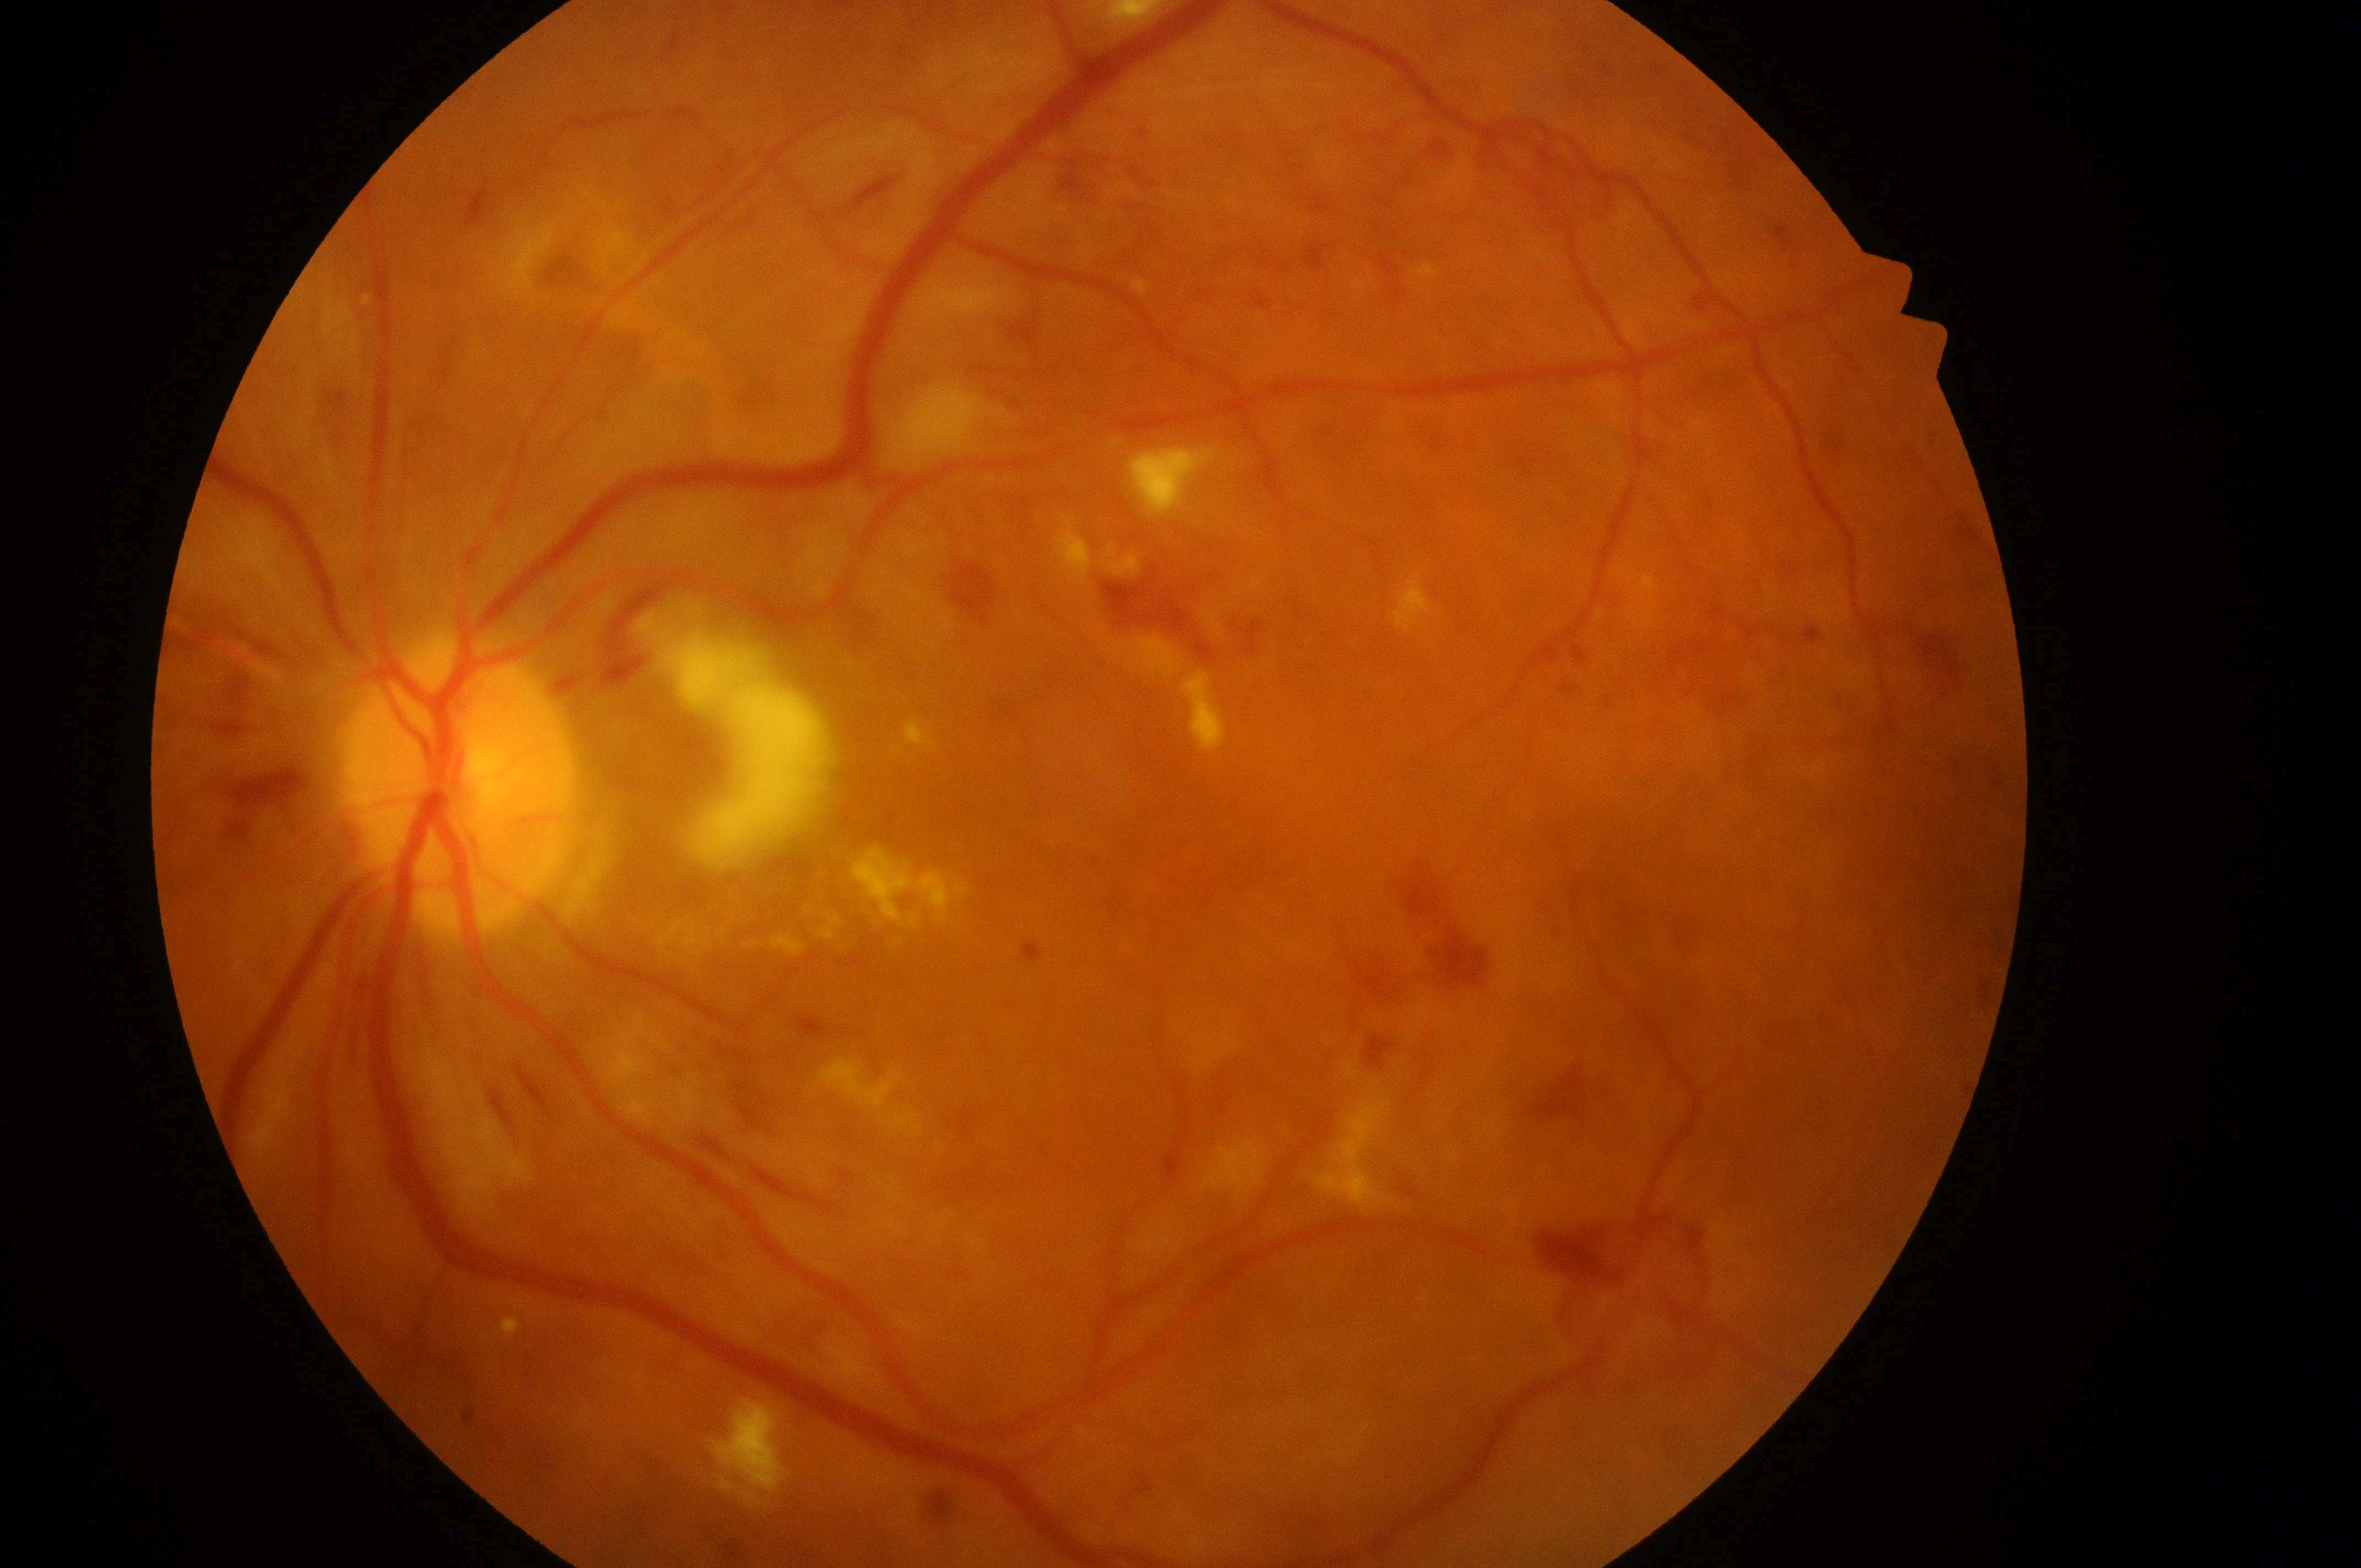

Annotations:
• DR class · proliferative diabetic retinopathy
• macular edema · grade 2 (high risk)
• macular center · 1200px, 853px
• laterality · left
• diabetic retinopathy · proliferative diabetic retinopathy (grade 4)
• optic disk · 458px, 798px